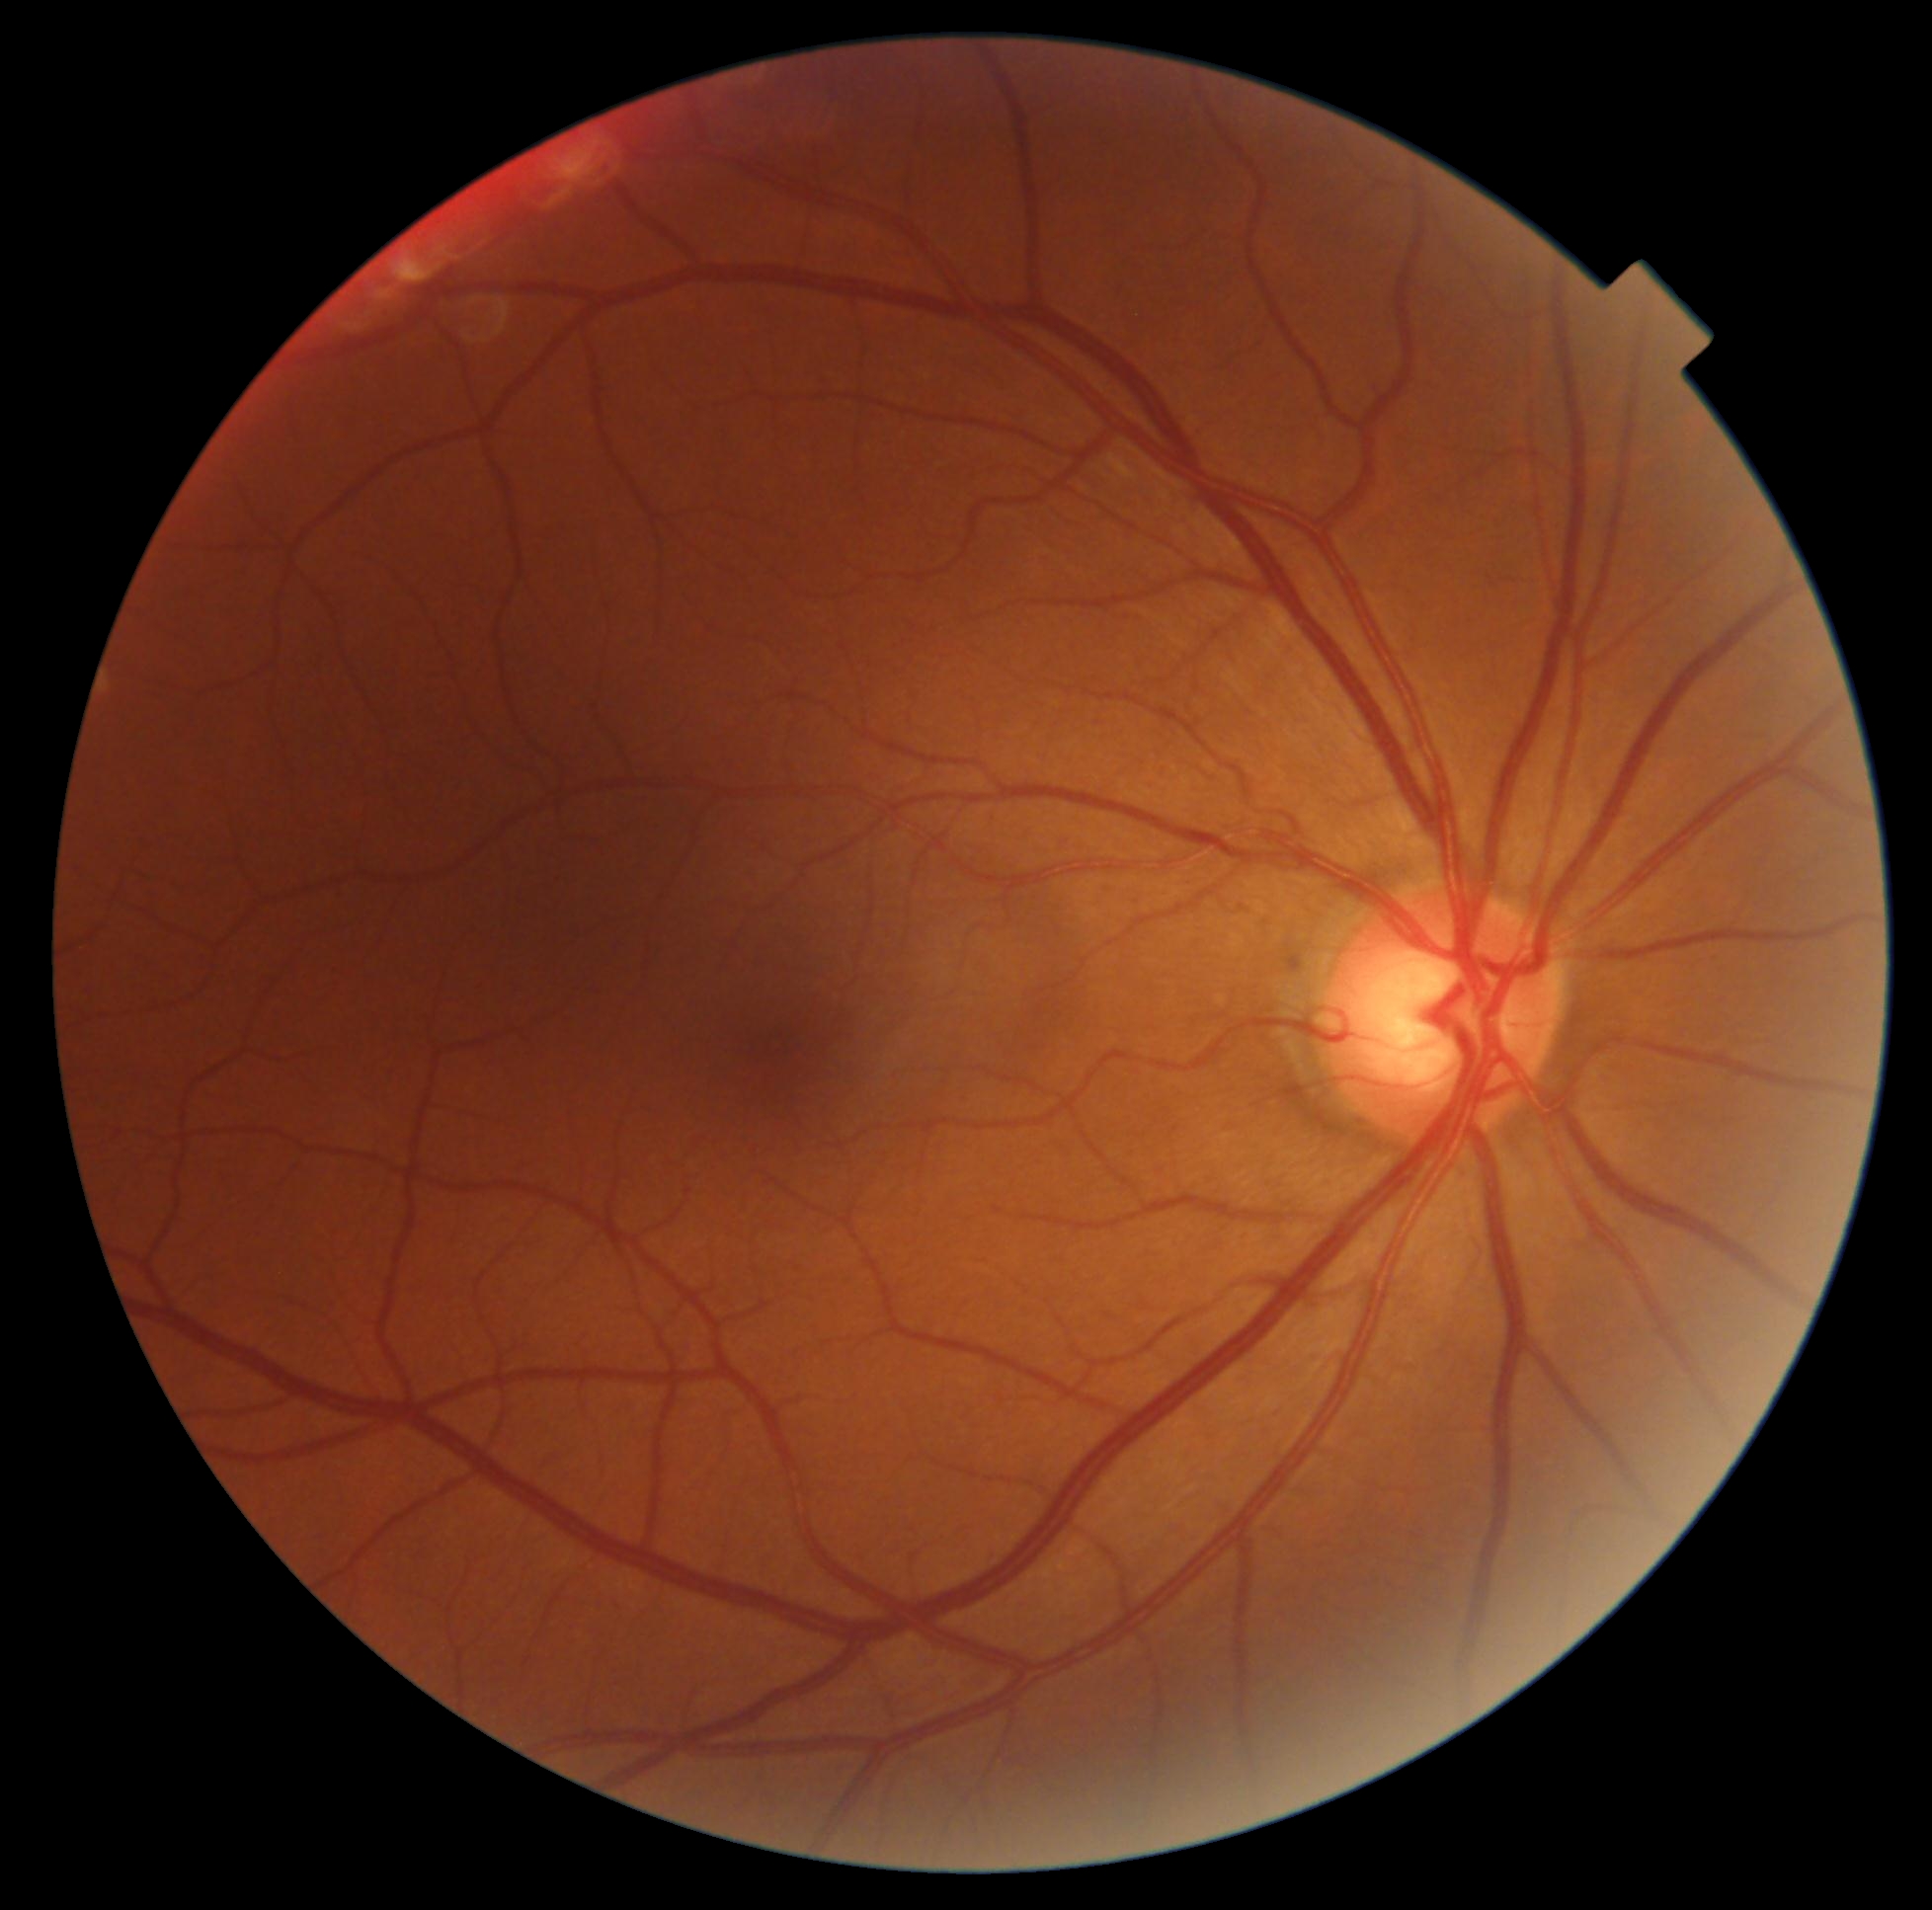 Diabetic retinopathy severity is grade 0.